Color fundus image · NIDEK AFC-230 · FOV: 45 degrees:
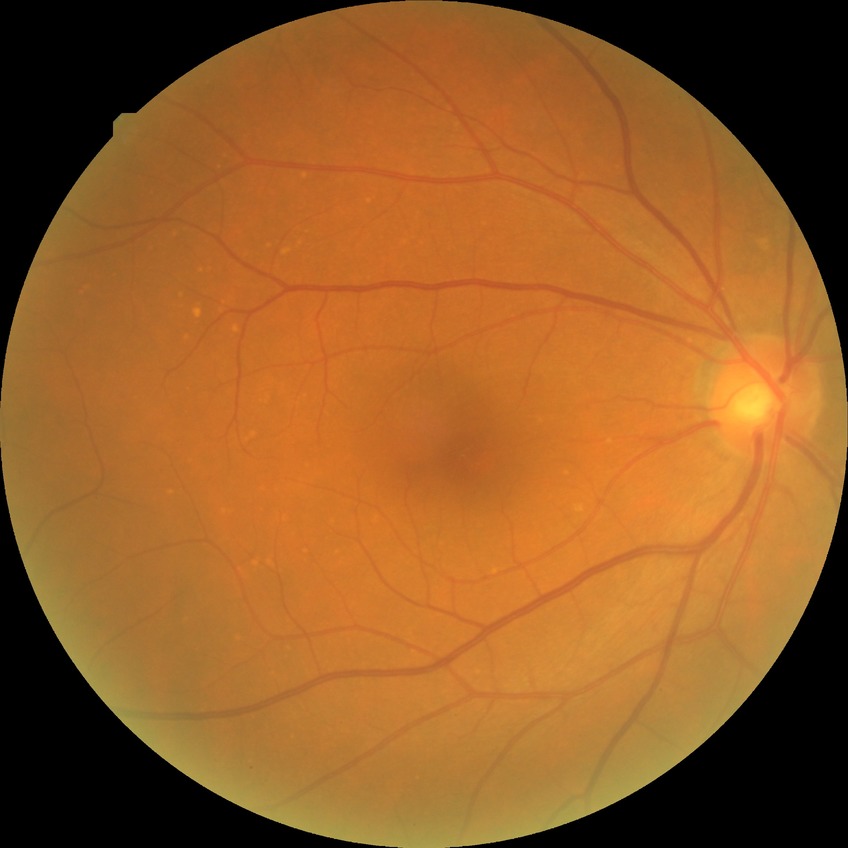

Modified Davis grading is no diabetic retinopathy.